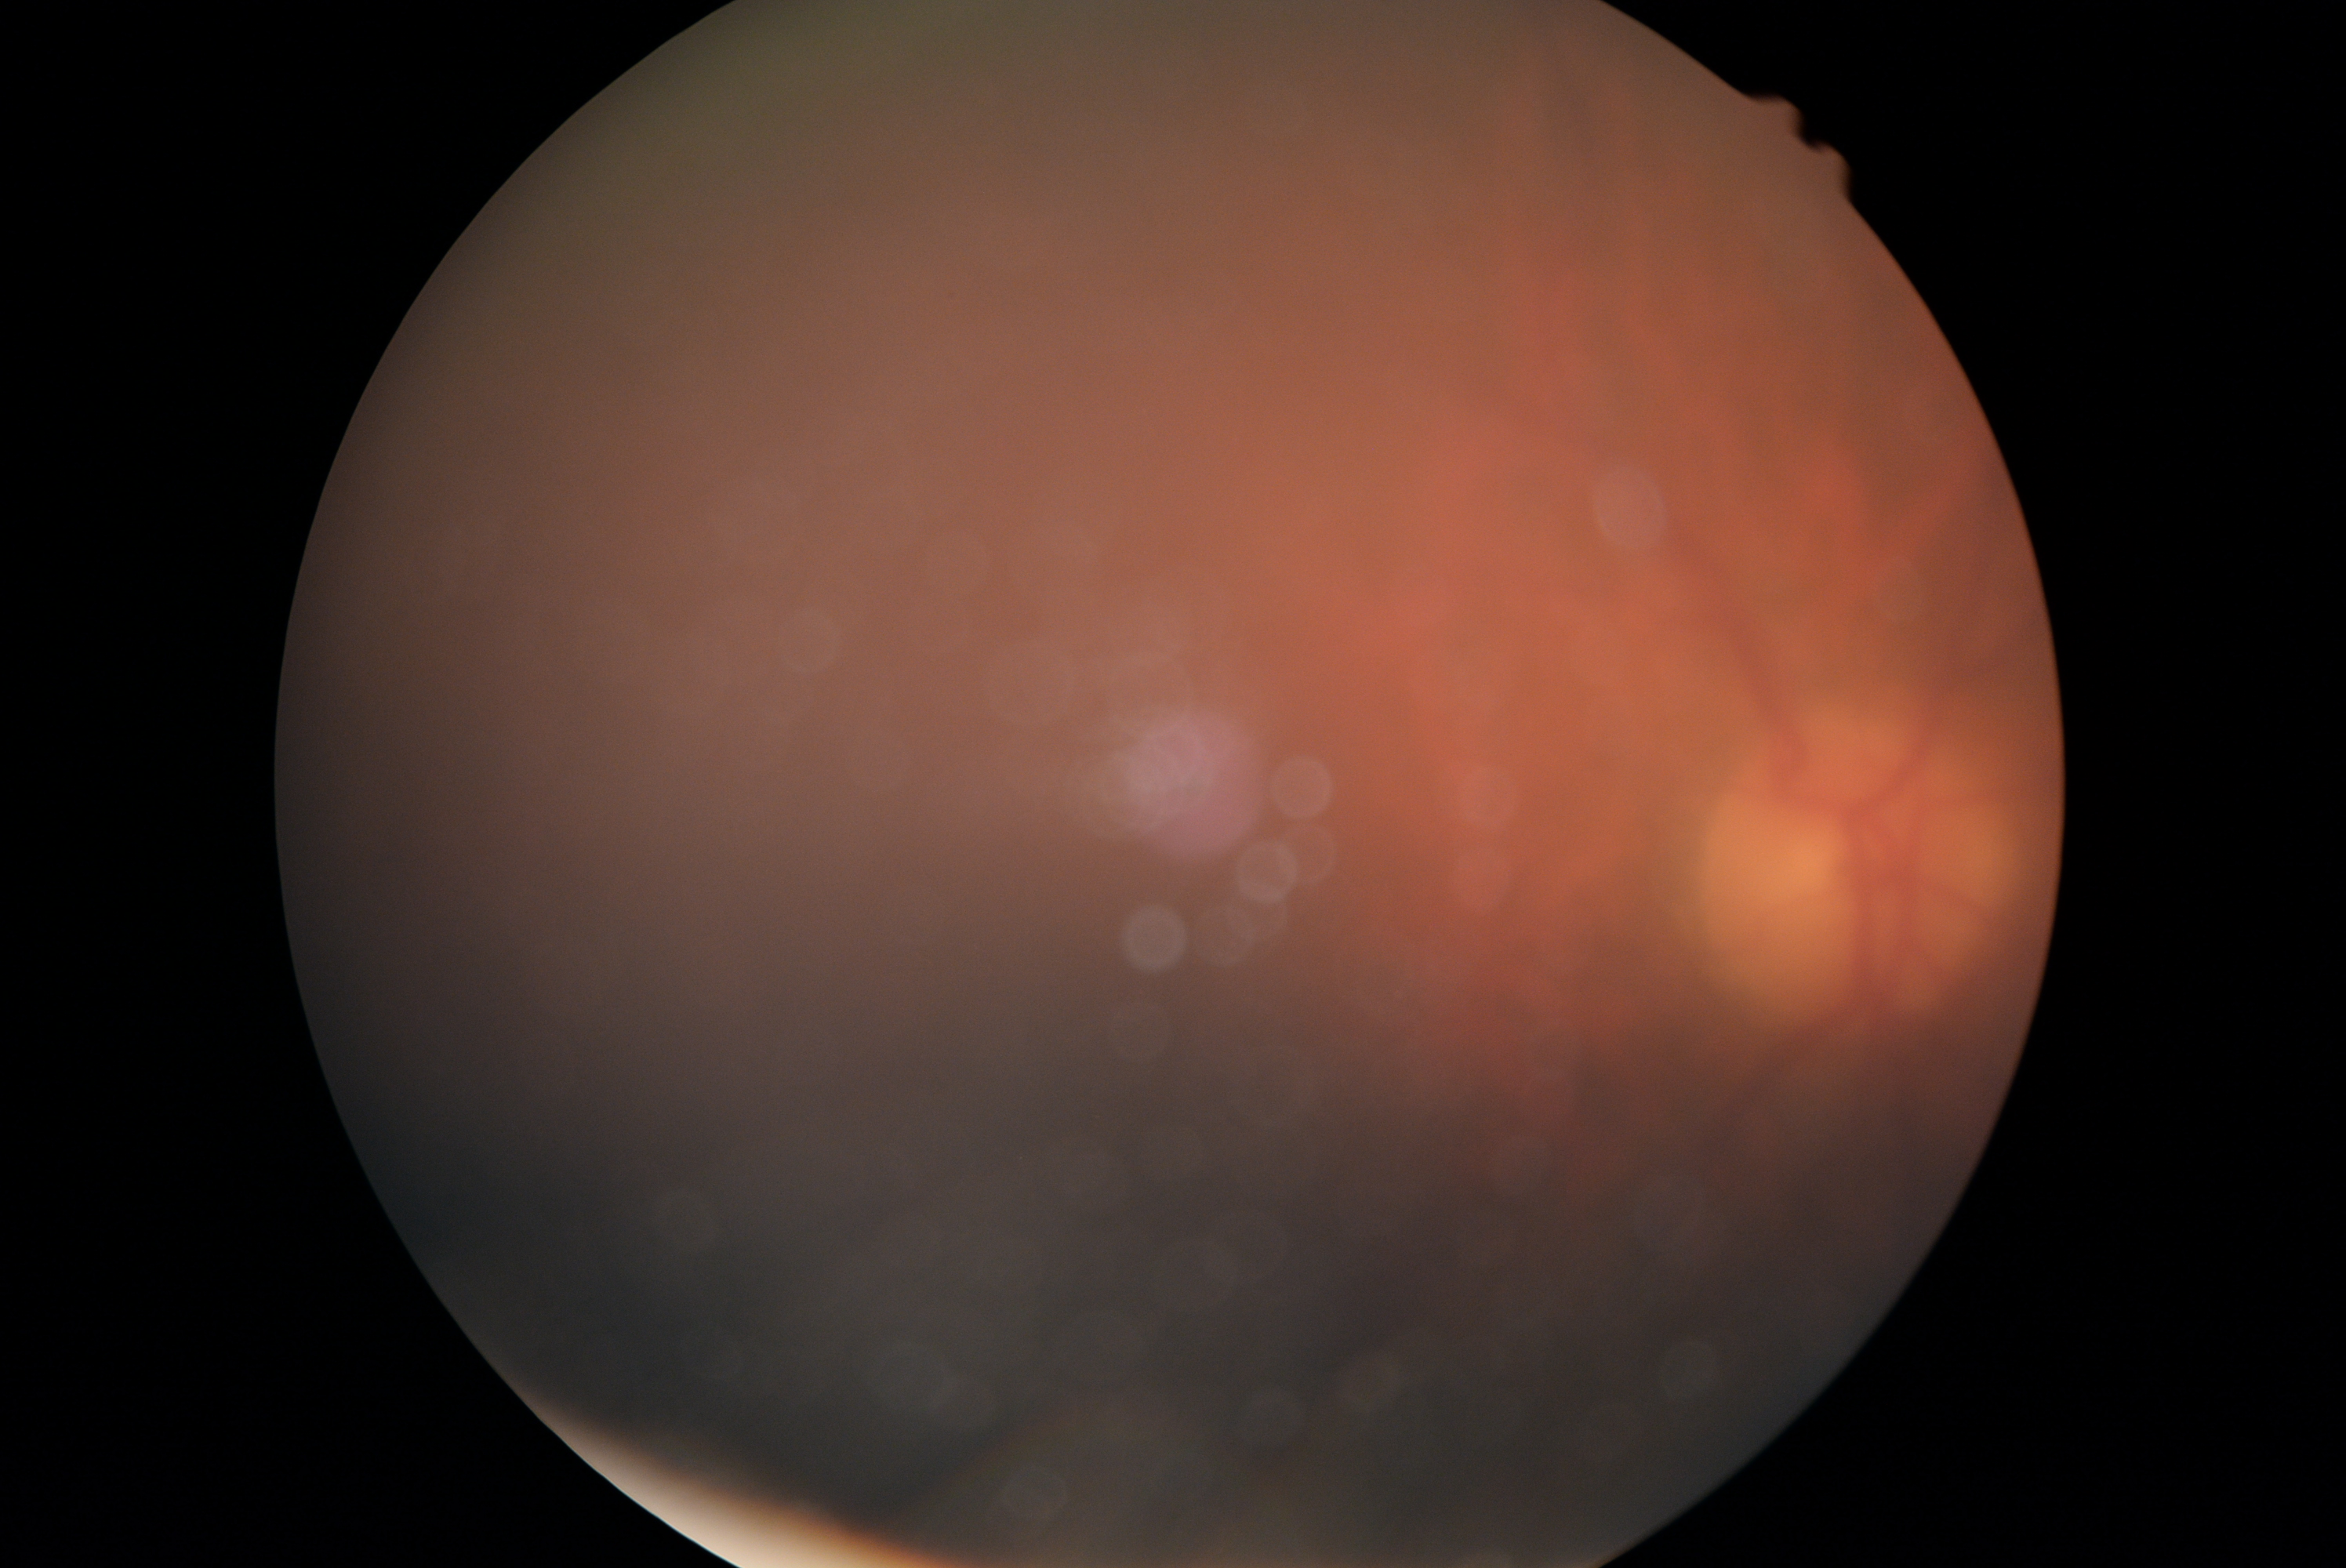
DR grade is ungradable due to poor image quality.